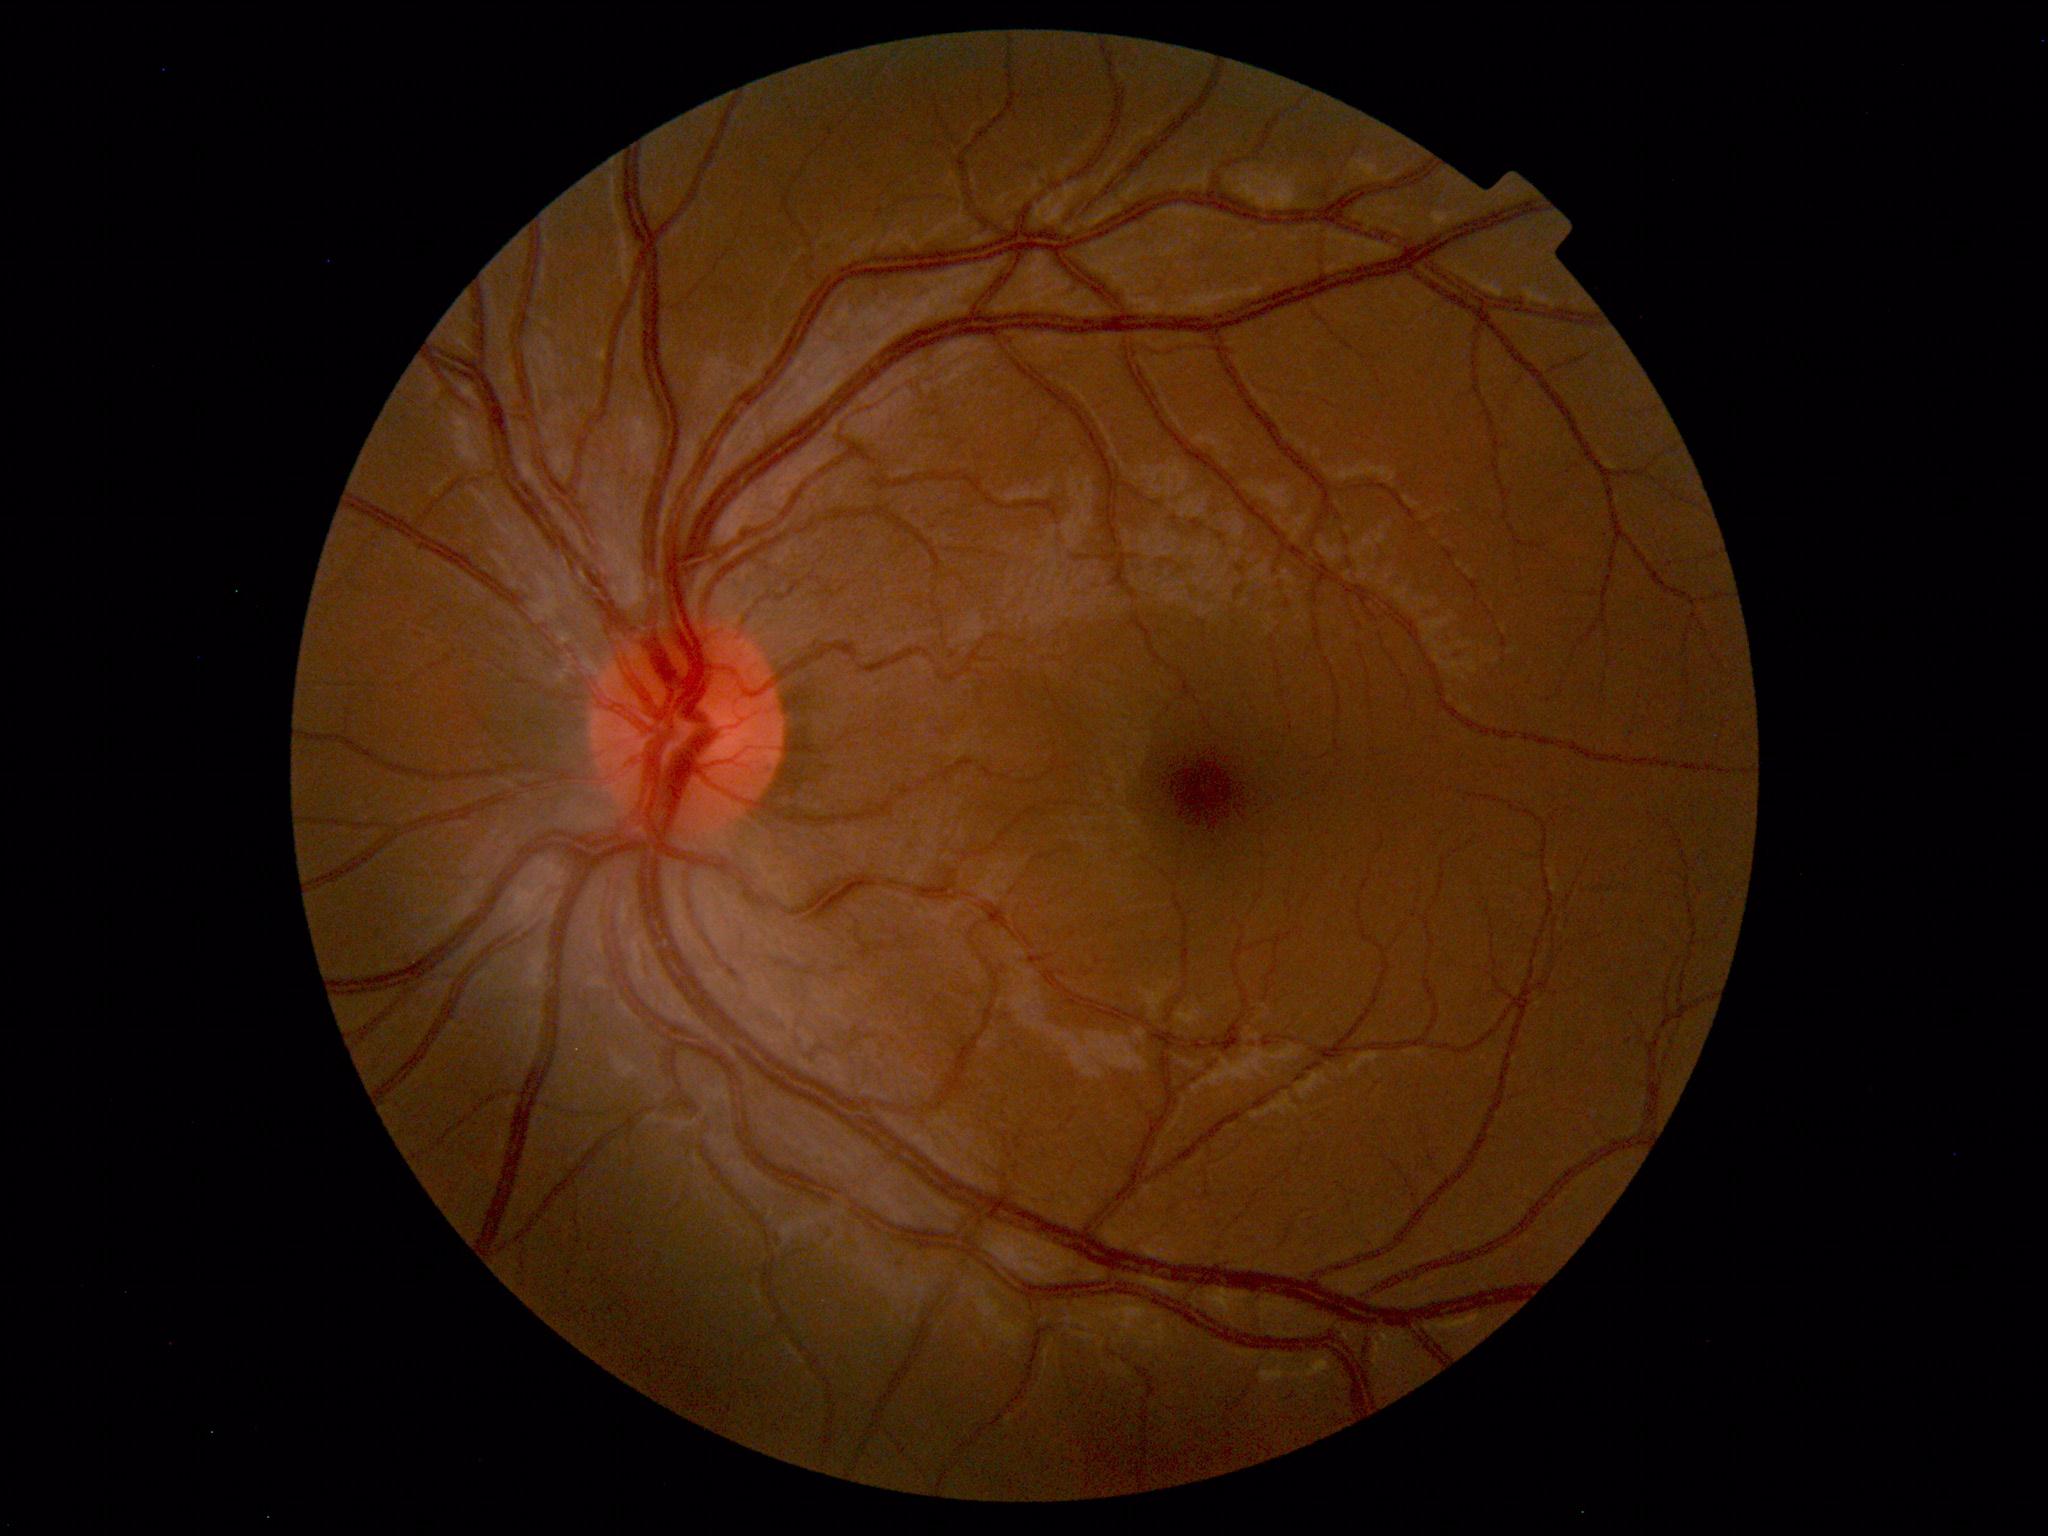 Fundus photograph within normal limits.